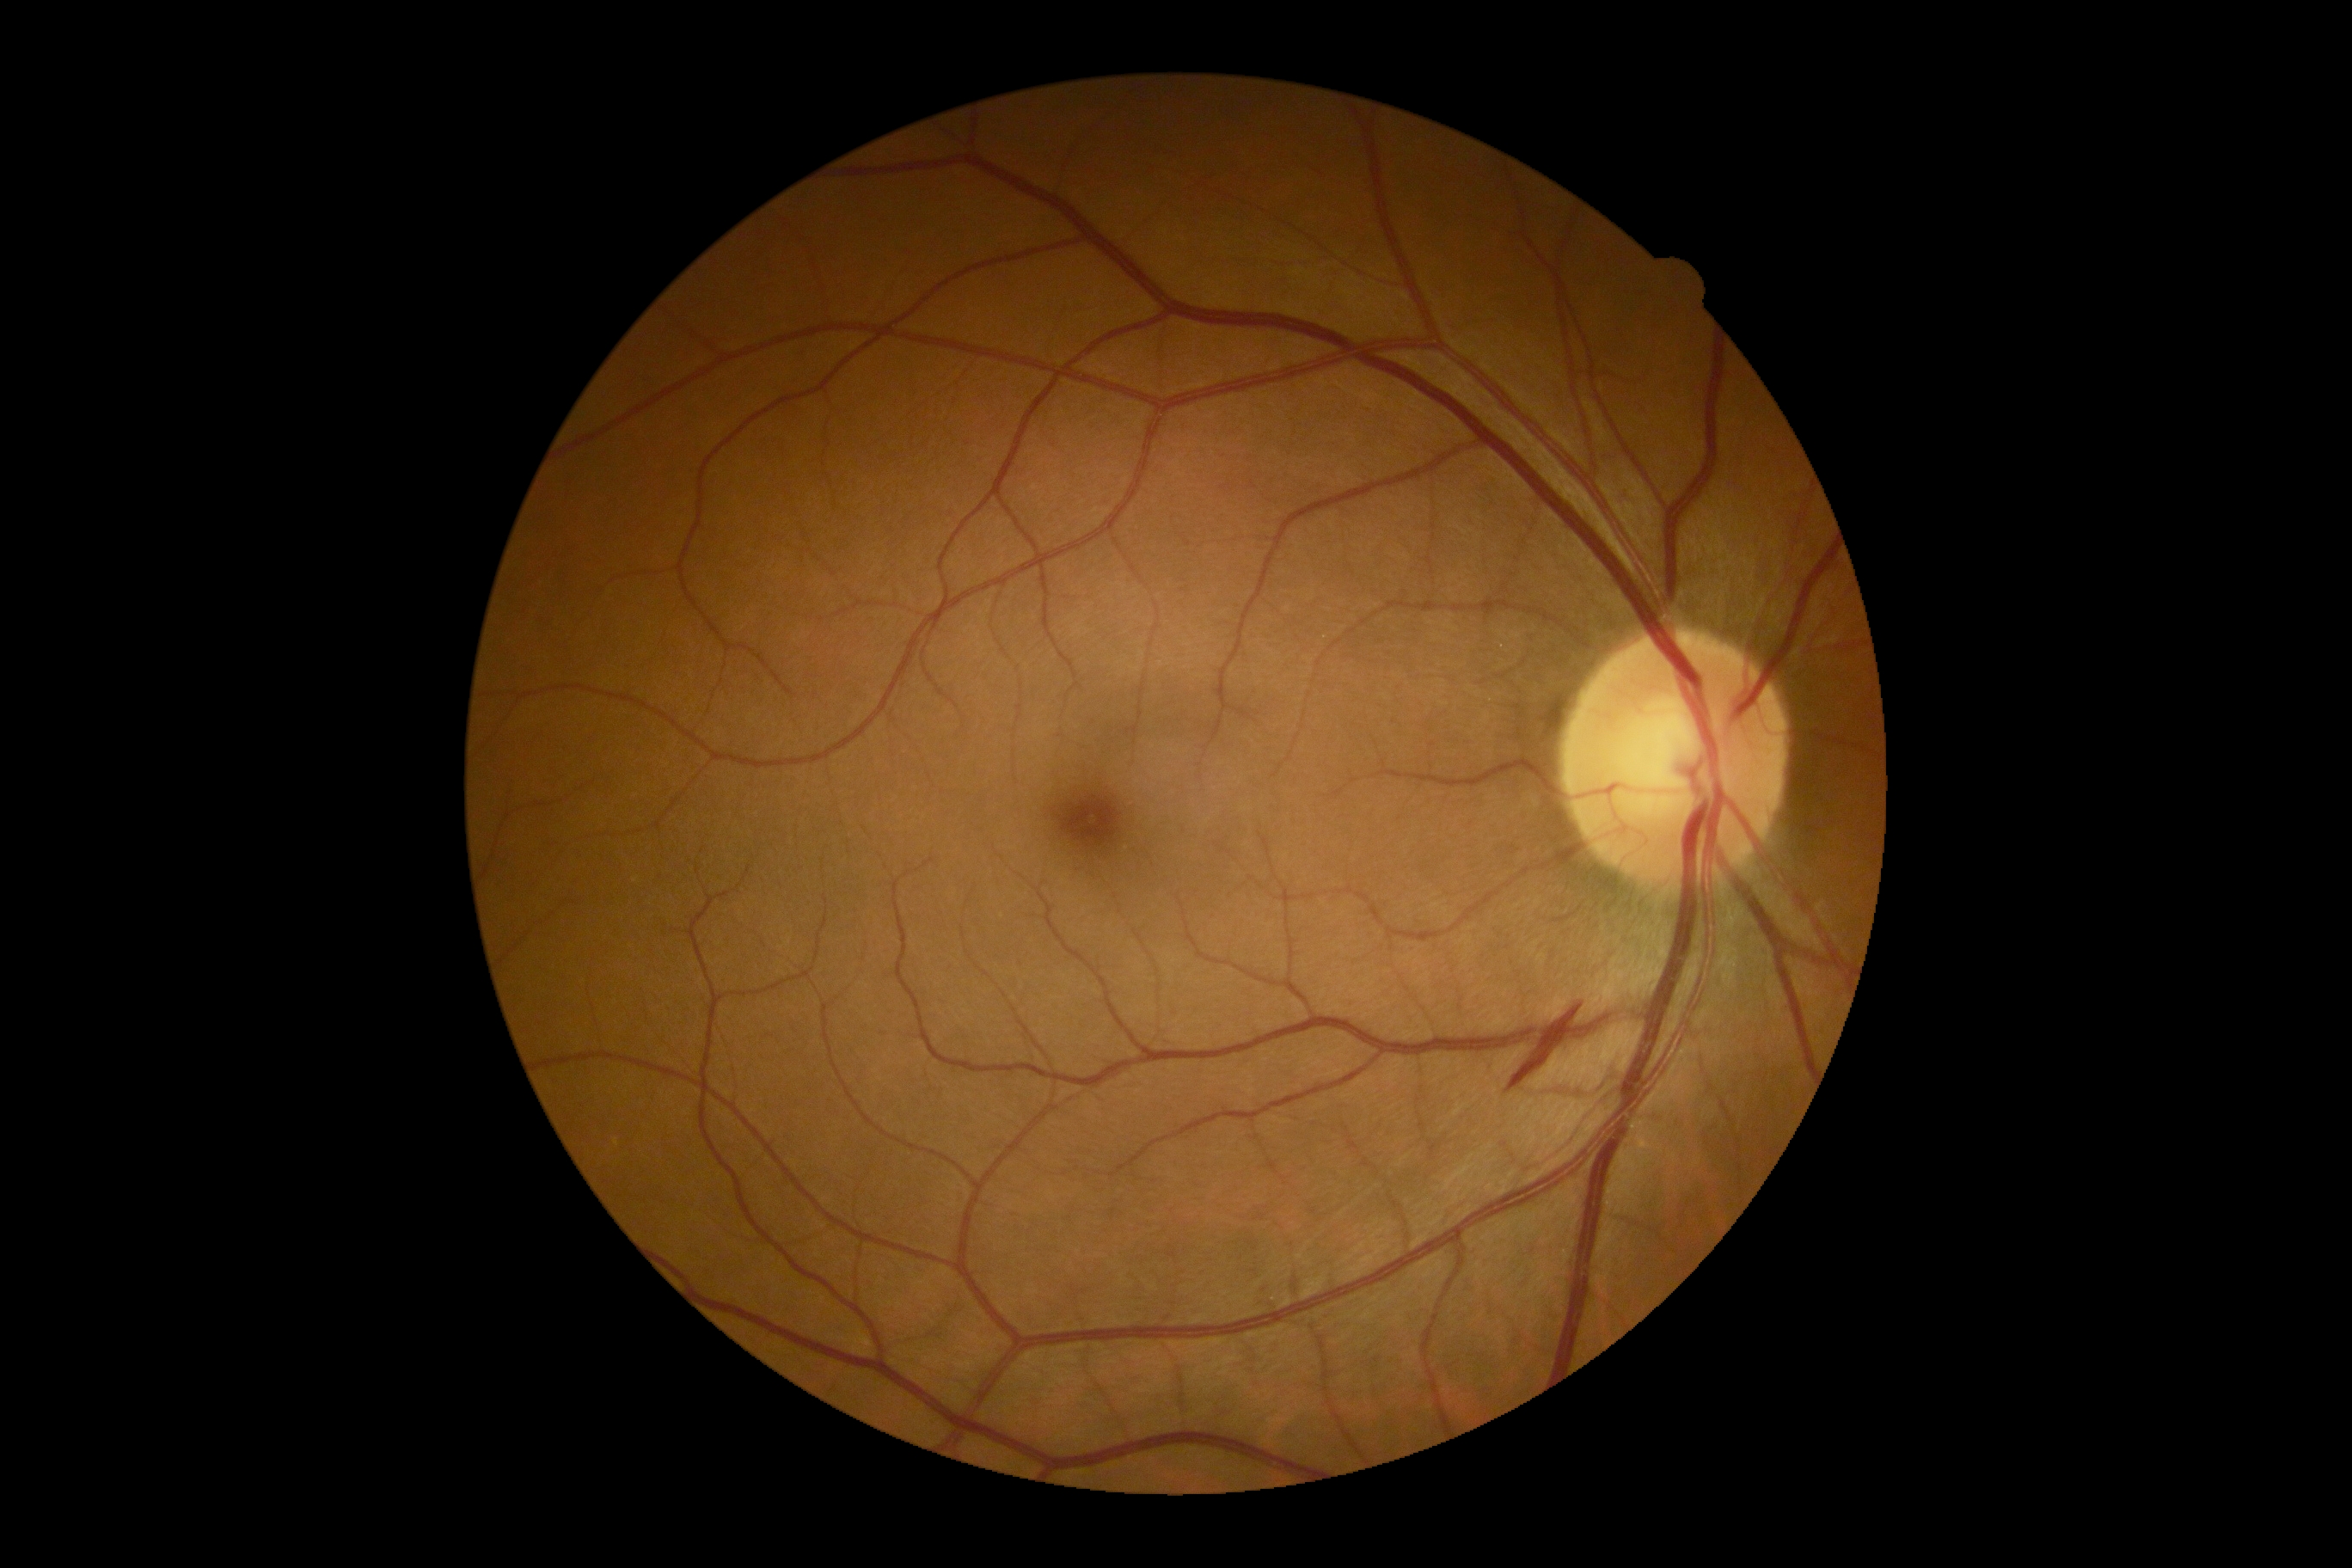

{"dr_grade": "grade 2 (moderate NPDR)"}